Infant wide-field fundus photograph: 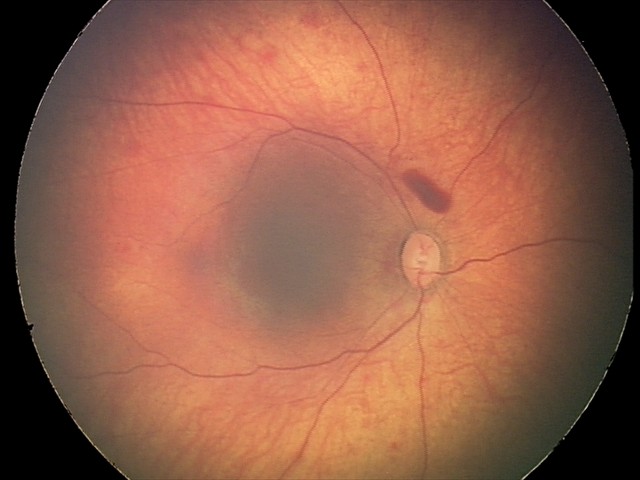 Screening series with retinal hemorrhages.